Wide-field fundus photograph from neonatal ROP screening: 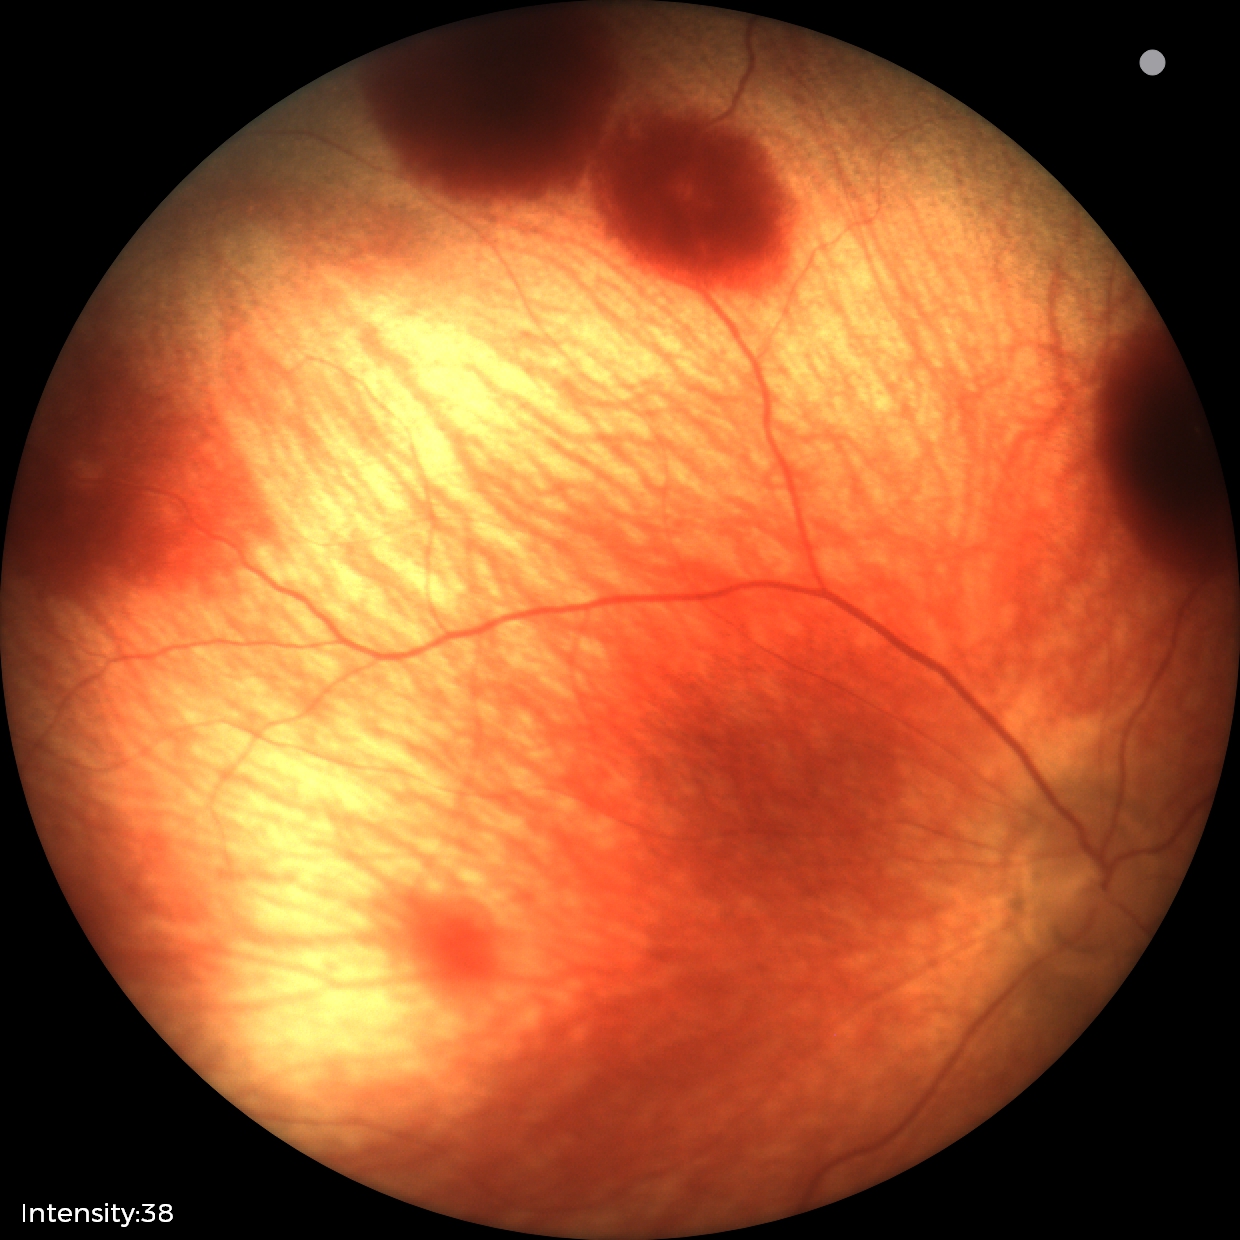

Screening series with retinal hemorrhages.